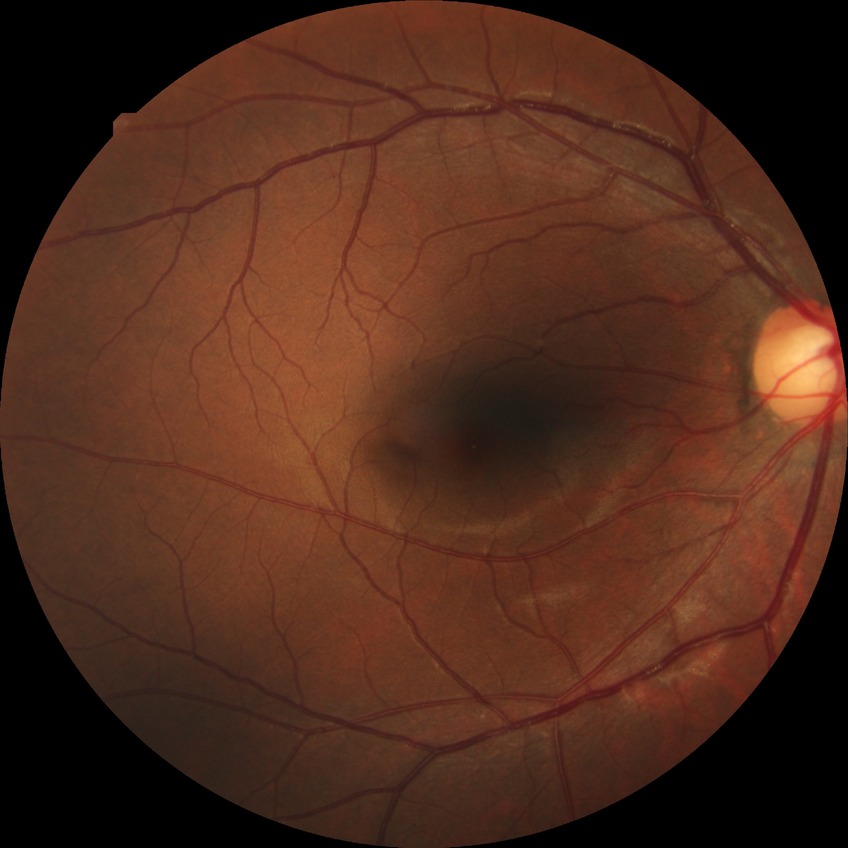 Assessment:
• retinopathy stage: no diabetic retinopathy